CFP
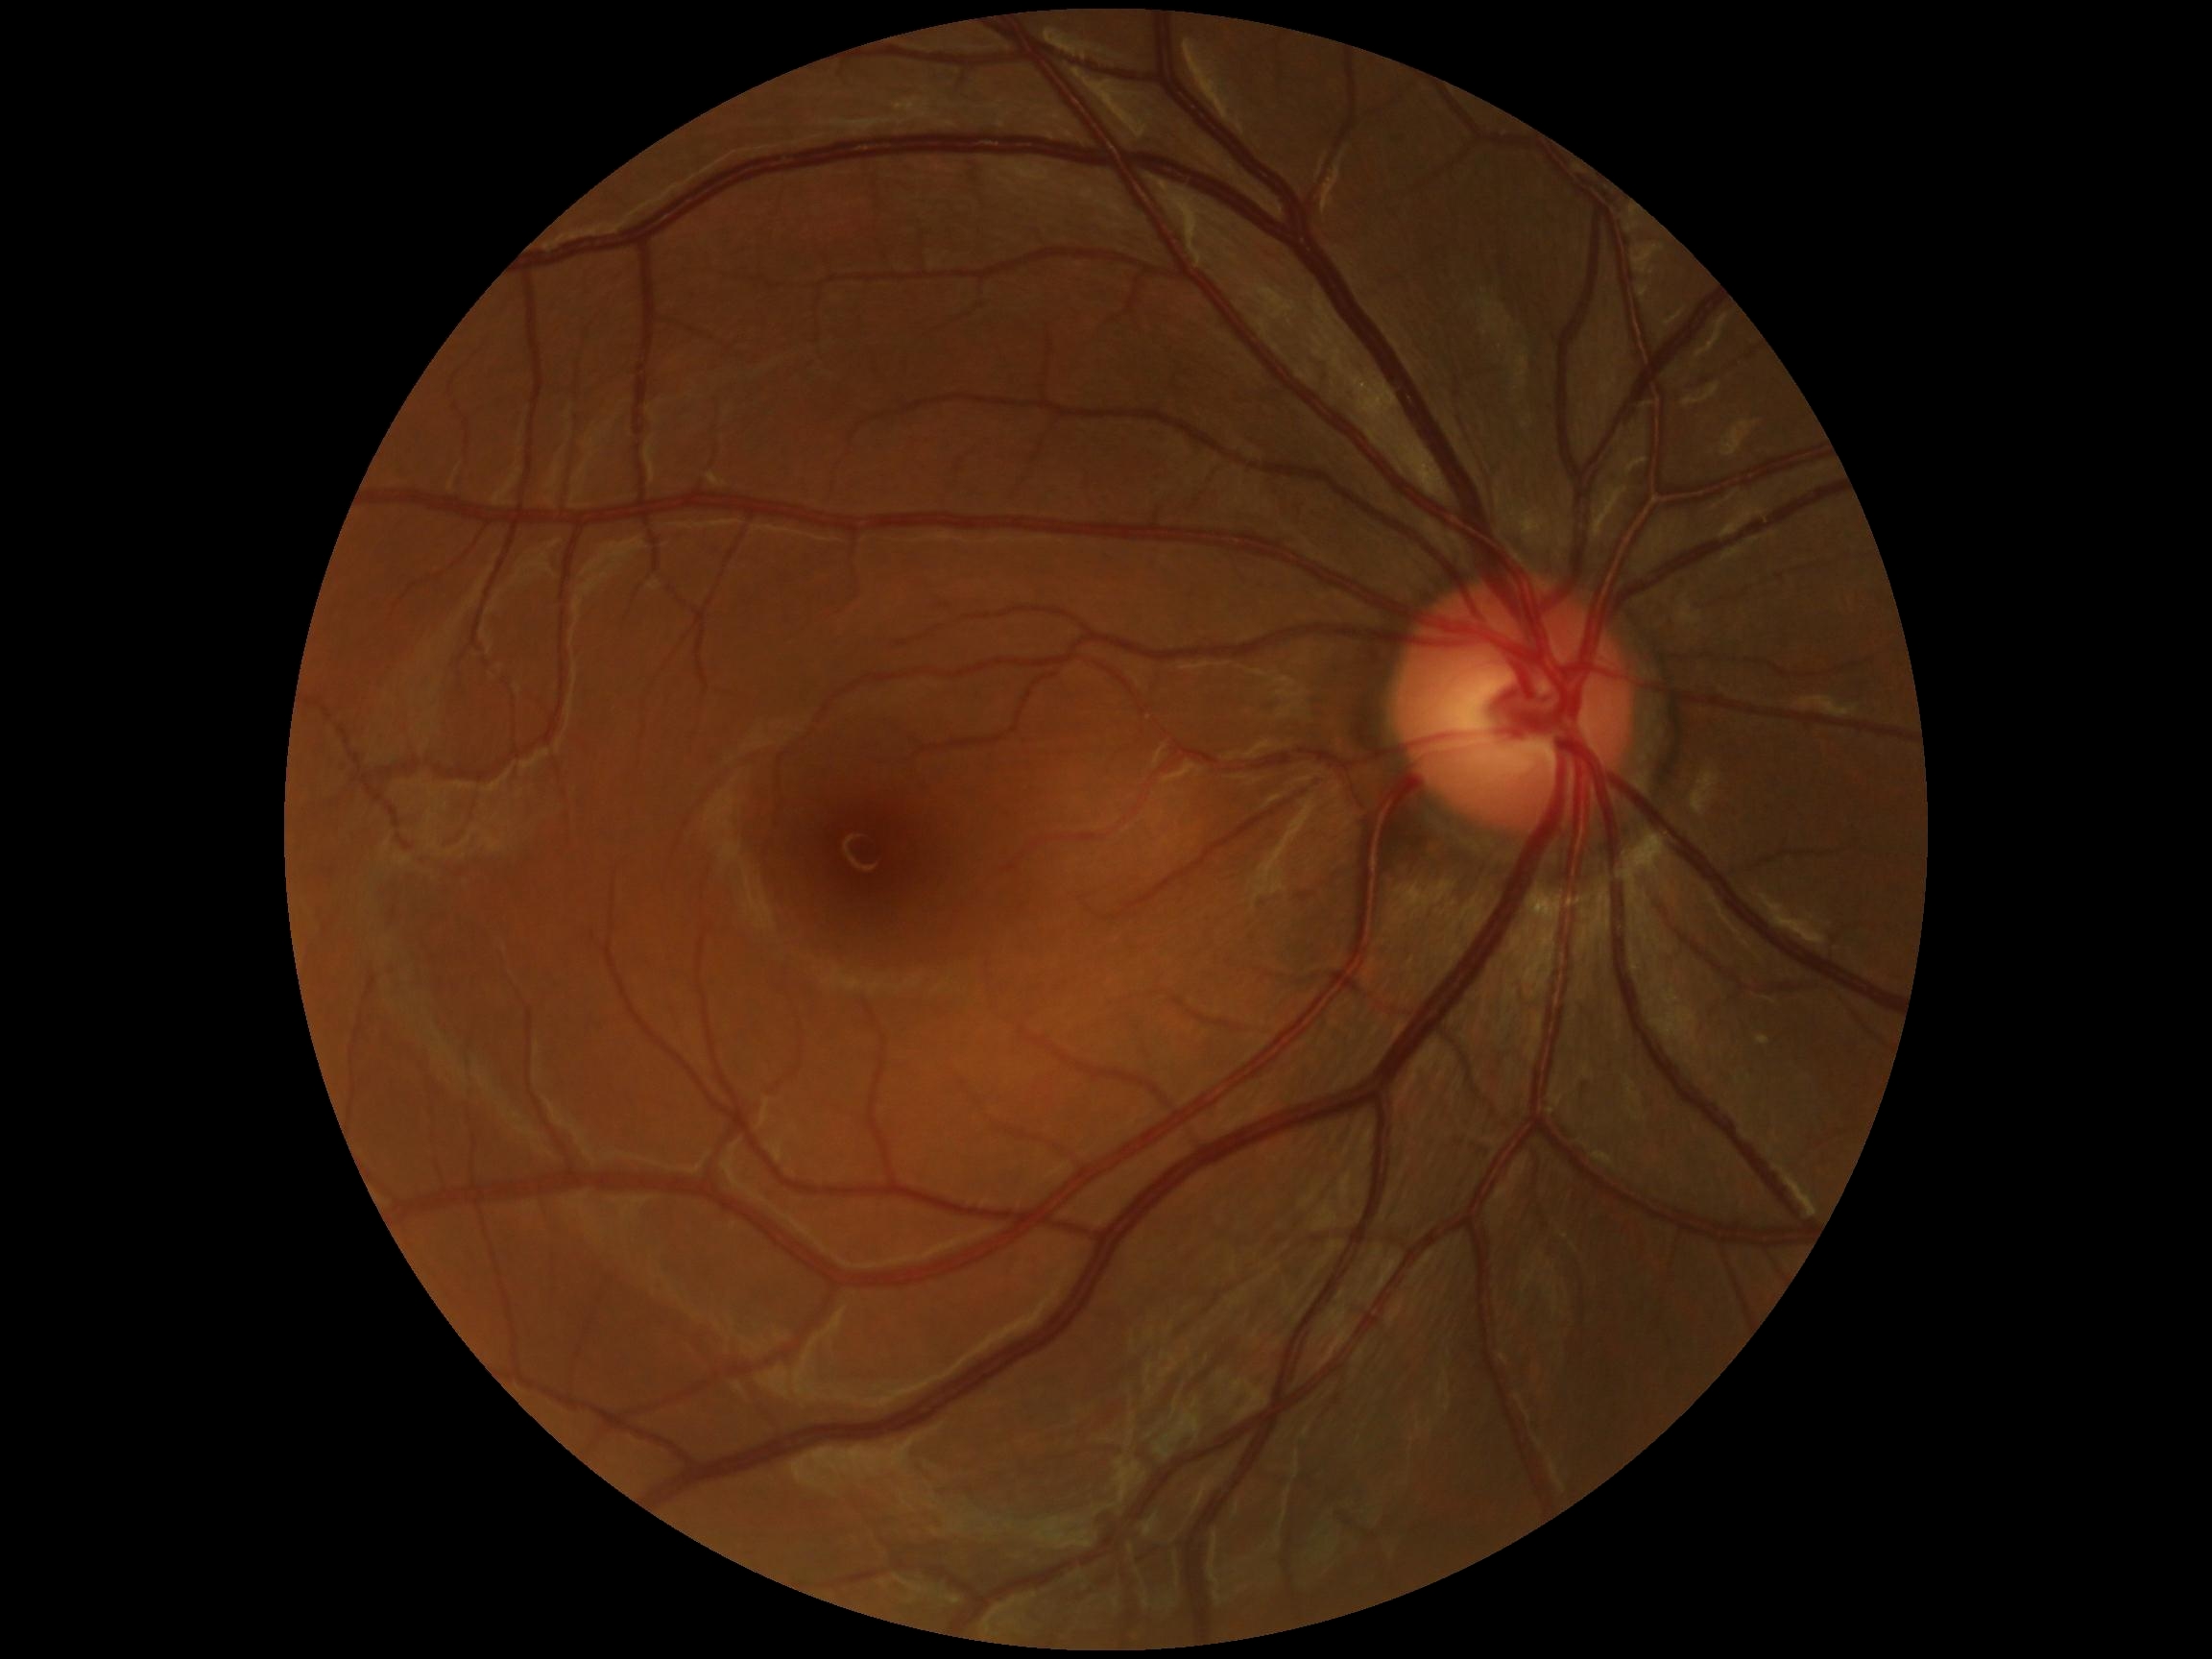 • DR impression: no signs of DR
• DR severity: 0/4